848x848; camera: NIDEK AFC-230; 45° FOV; no pharmacologic dilation
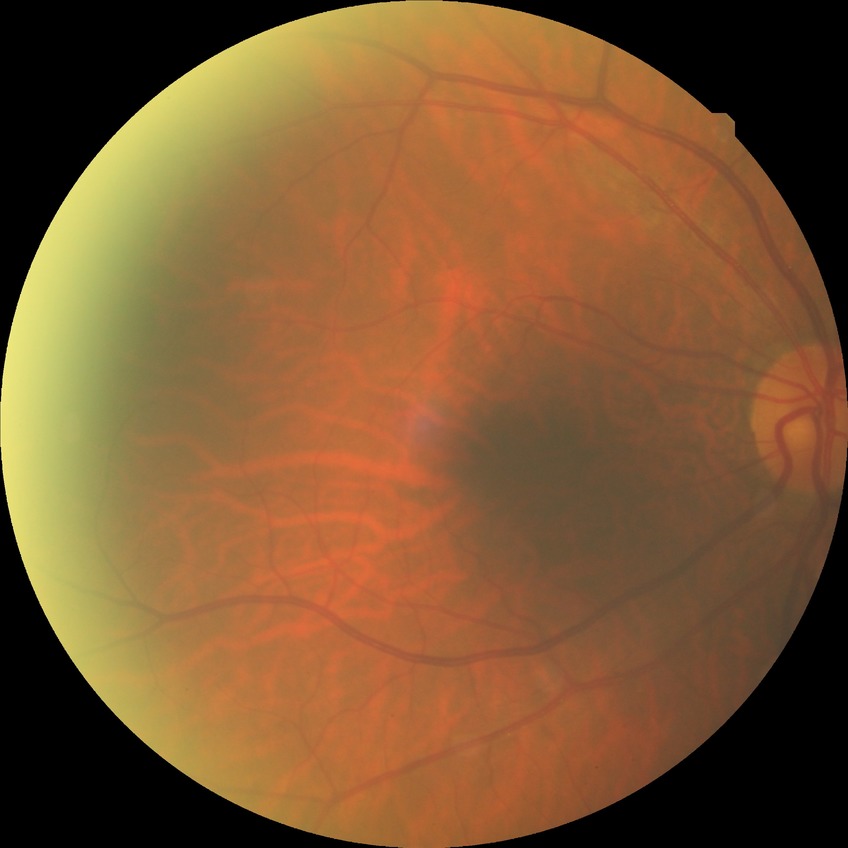
Diabetic retinopathy (DR) is no diabetic retinopathy (NDR).